Wide-field fundus photograph of an infant. 1240 x 1240 pixels.
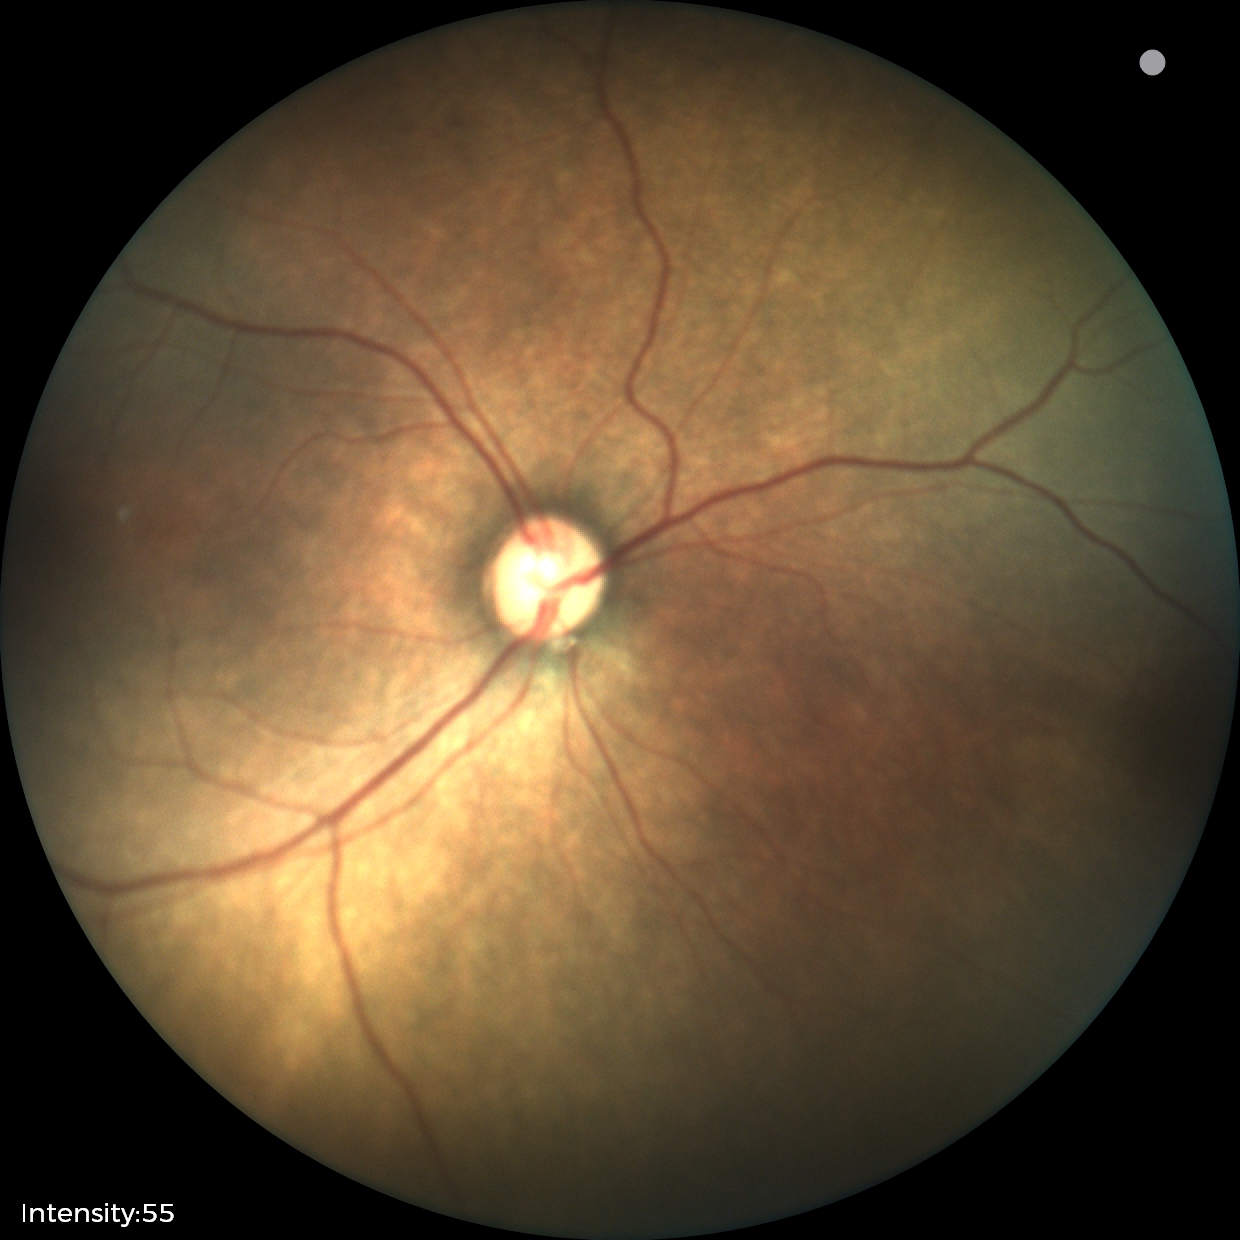 Plus disease absent. Diagnosis from this screening exam: status post ROP.